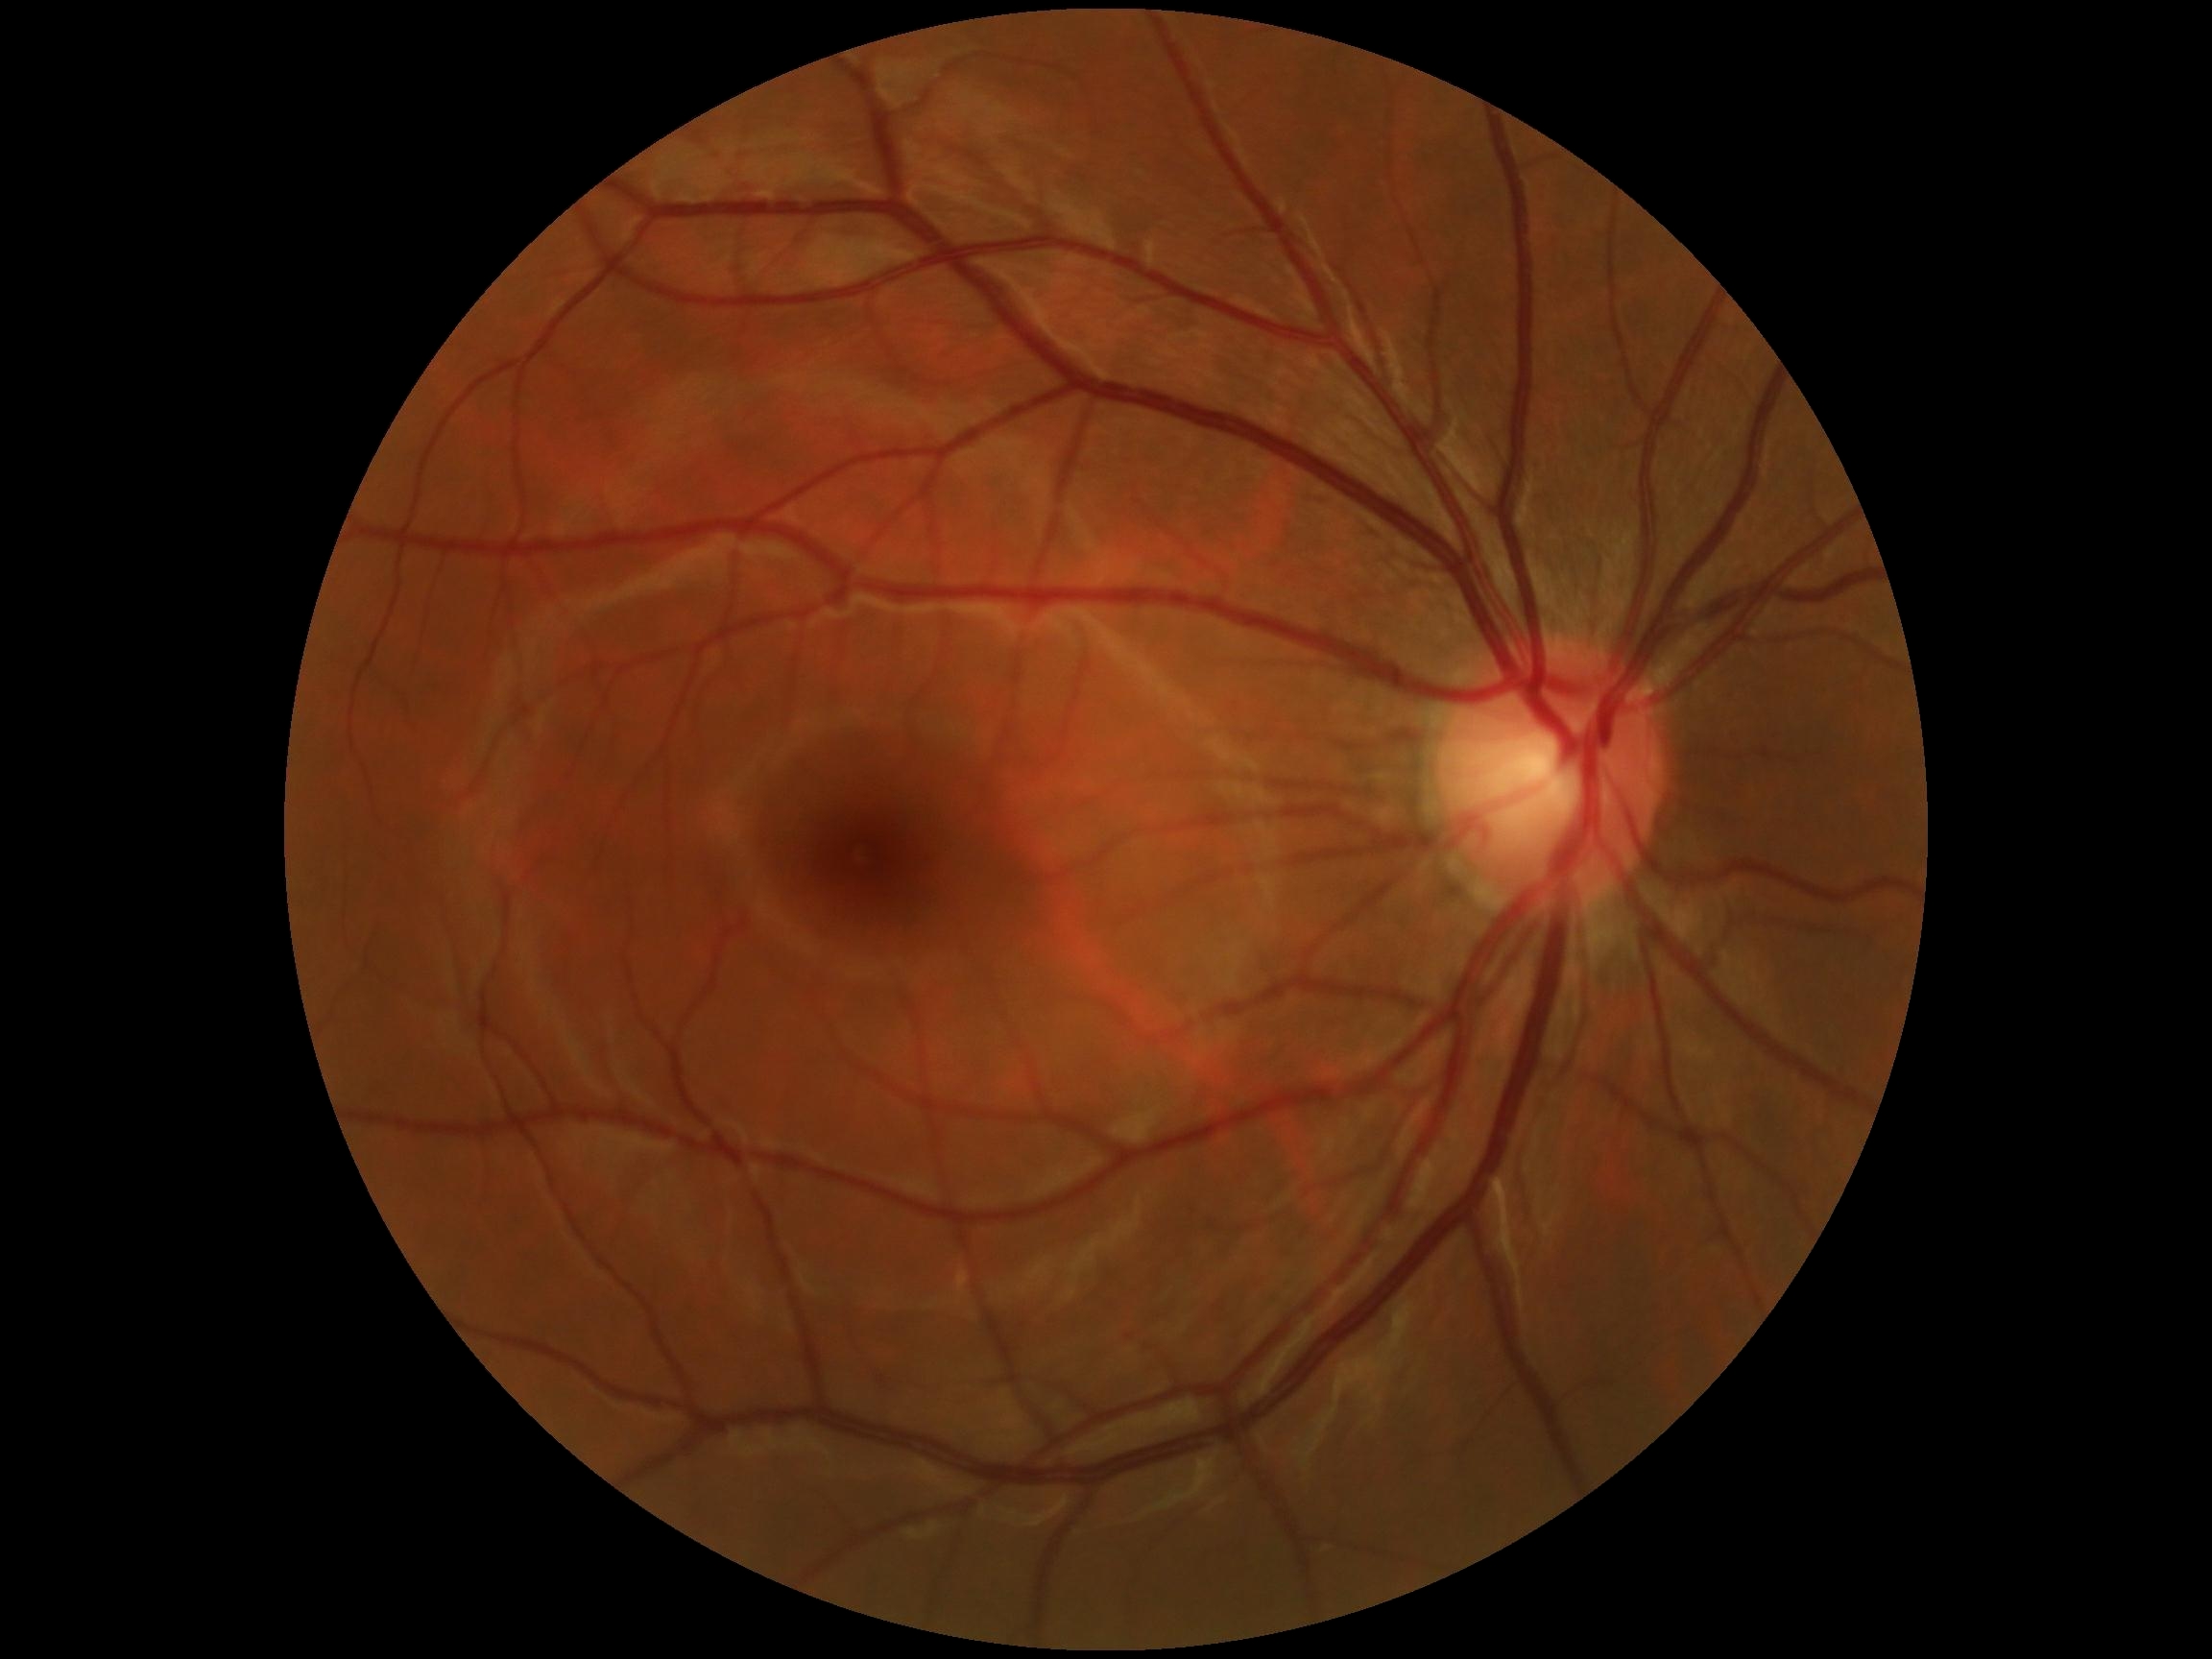
Diabetic retinopathy (DR): grade 0. No diabetic retinal disease findings.